848 by 848 pixels · modified Davis classification: 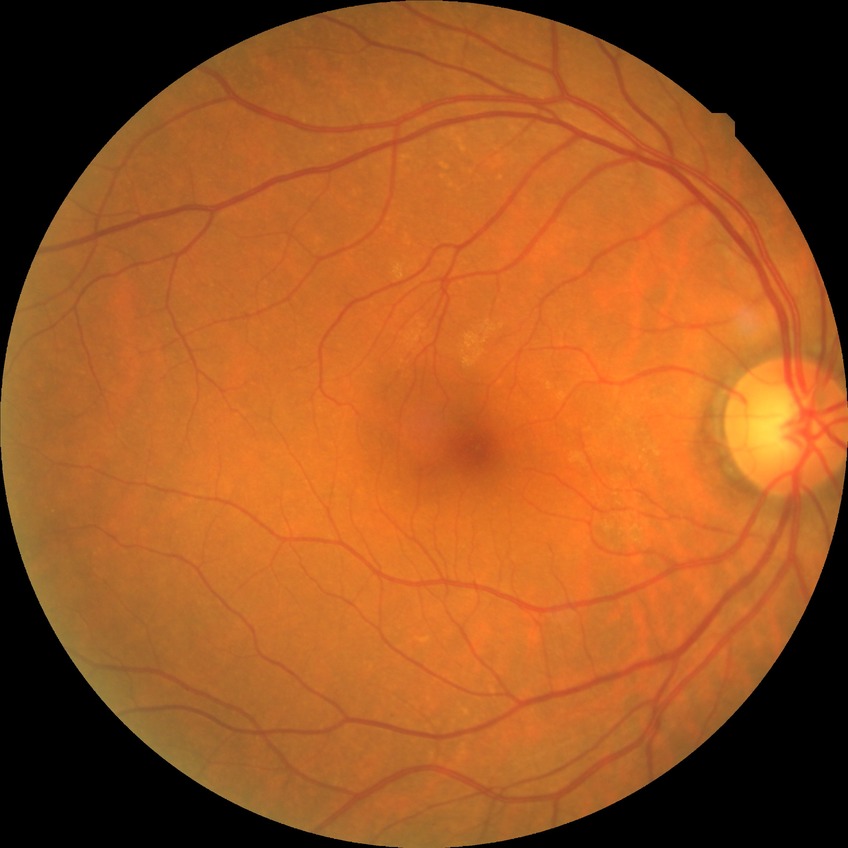
DR grade: NDR.